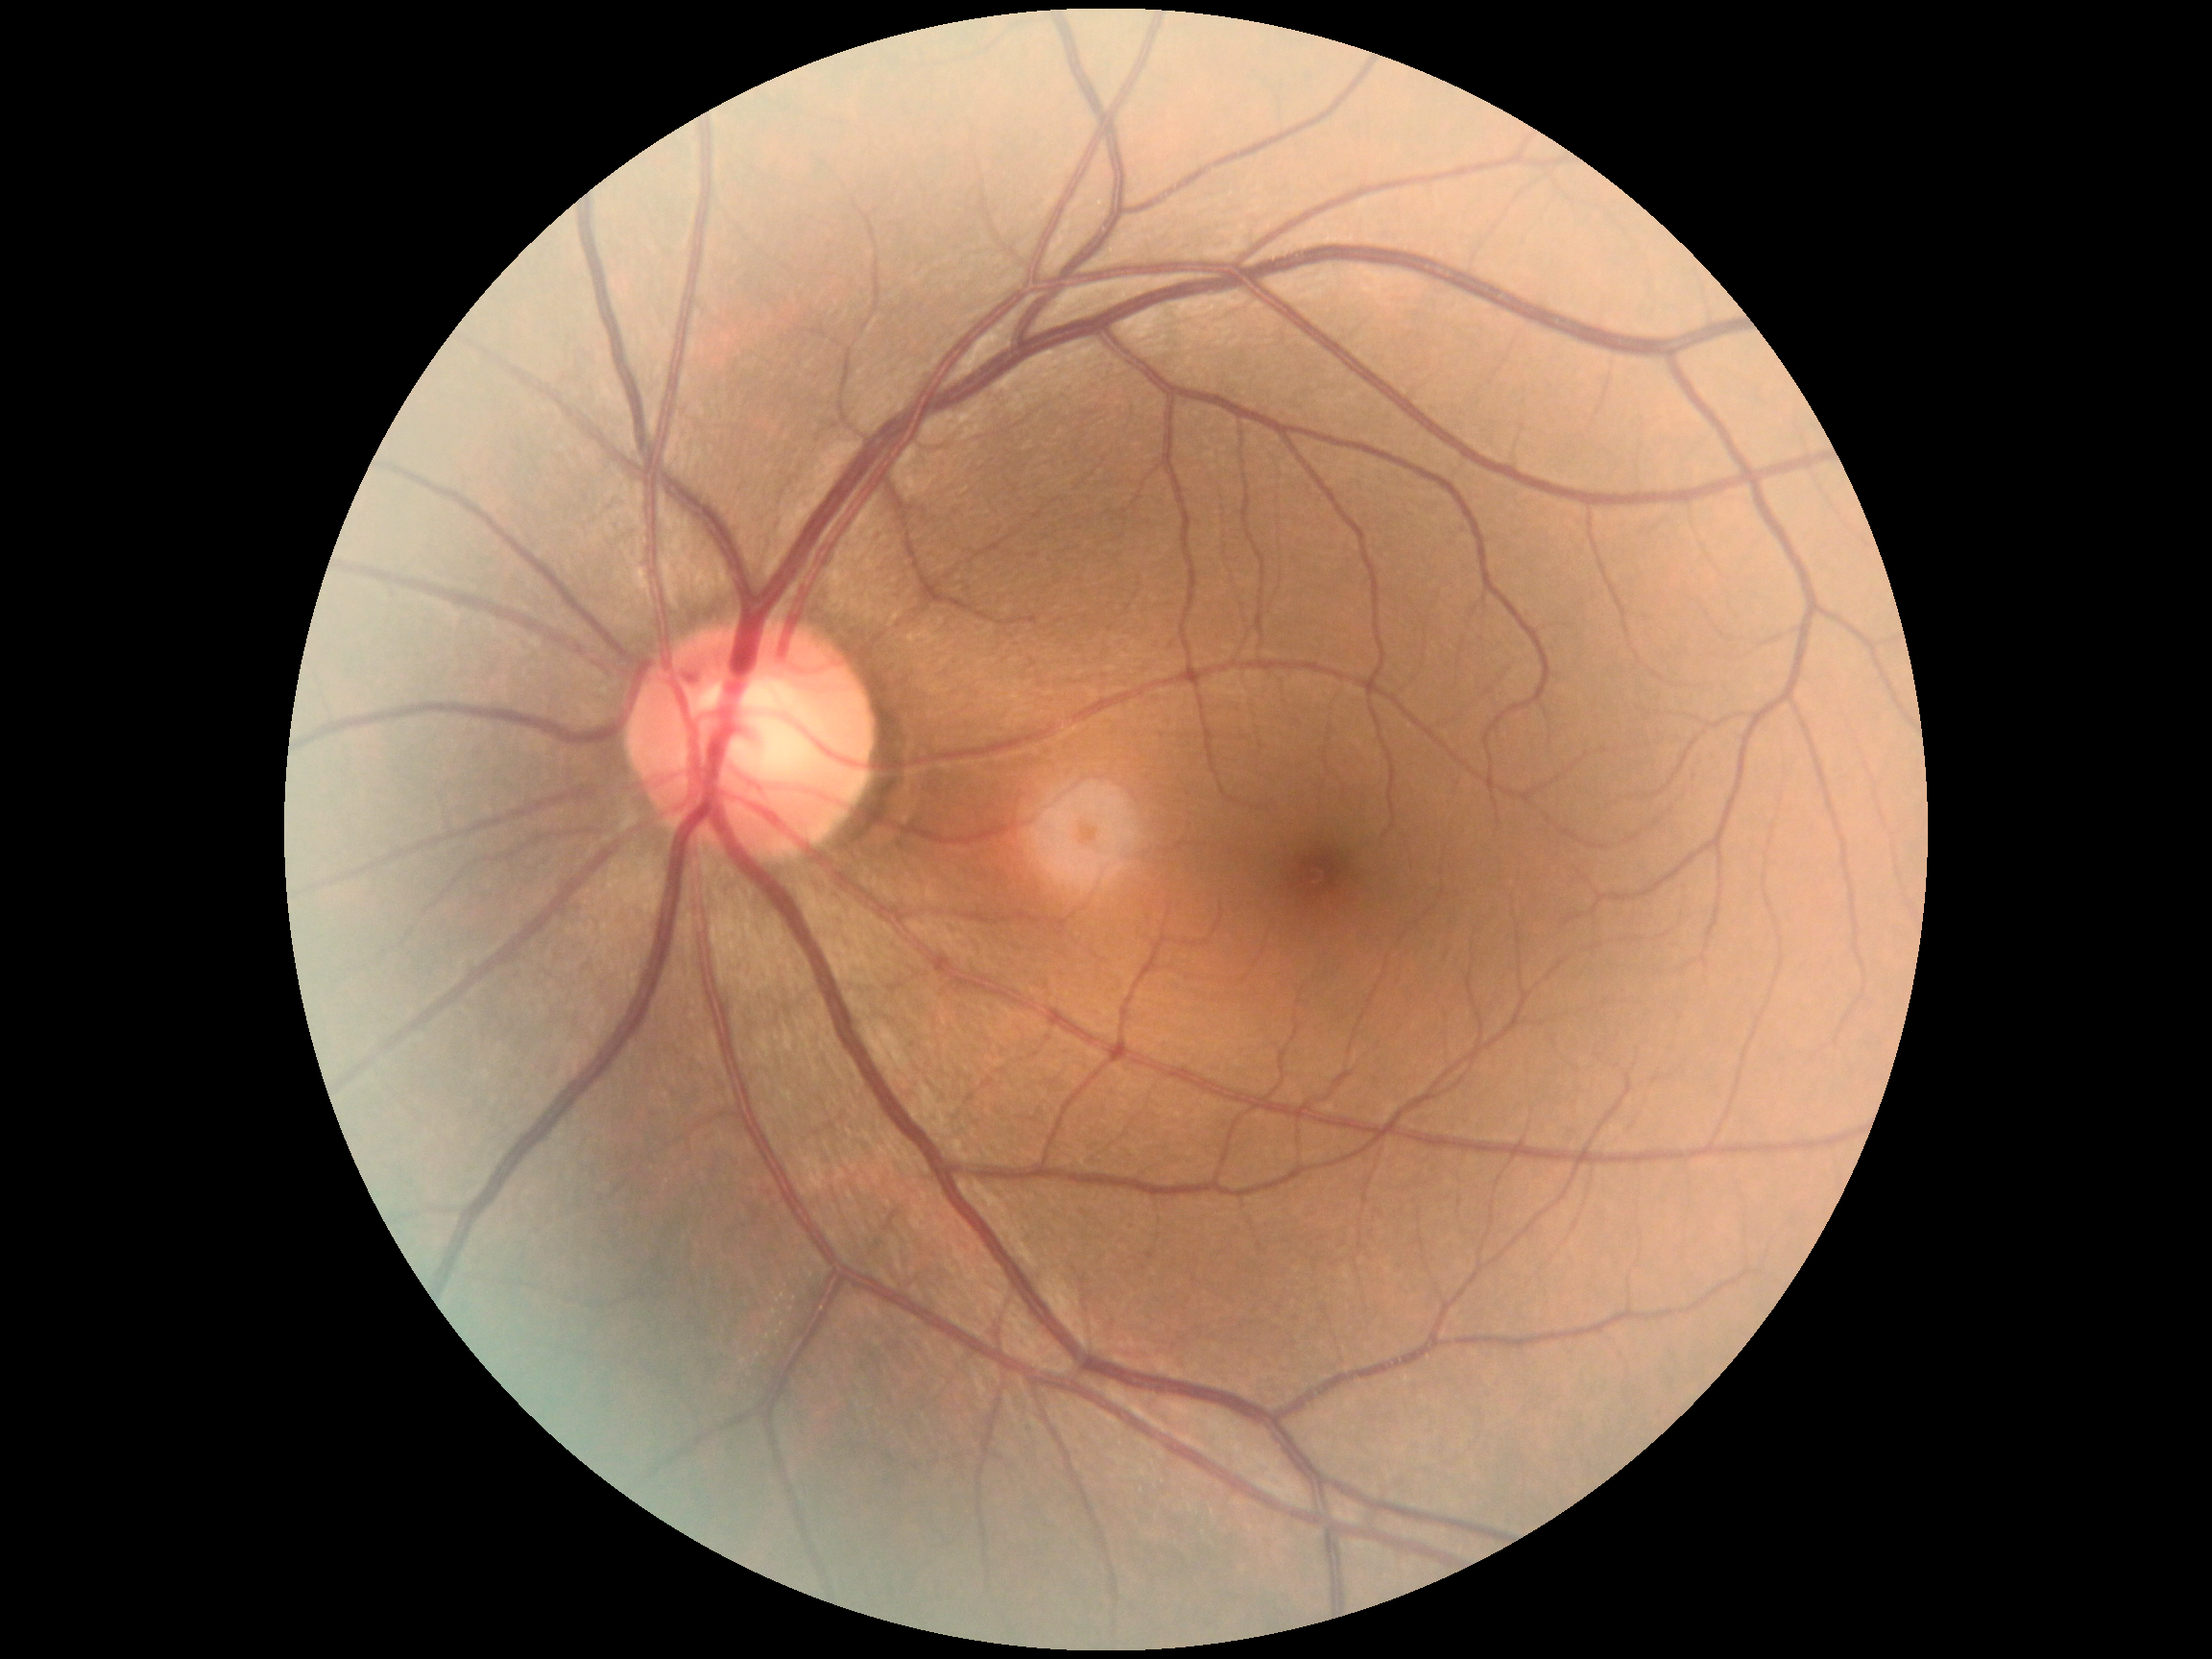

Retinopathy grade: 0 — no visible signs of diabetic retinopathy.